Clarity RetCam 3, 130° FOV; wide-field fundus photograph of an infant:
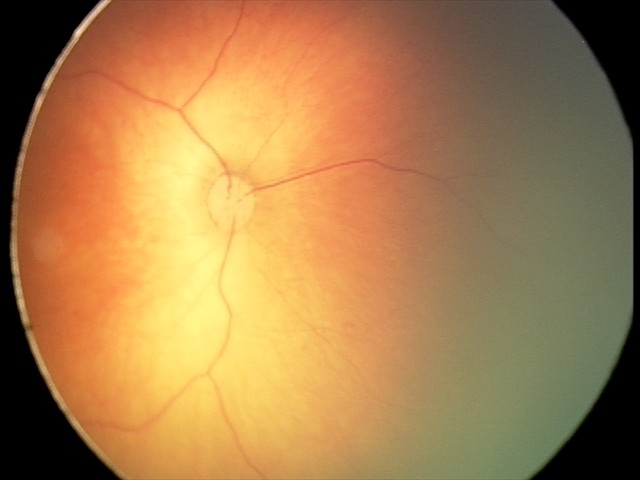 Physiological retinal appearance for postconceptual age.